Disc-centered field: 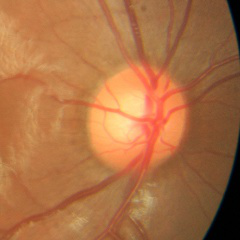
Assessment: no evidence of glaucoma.